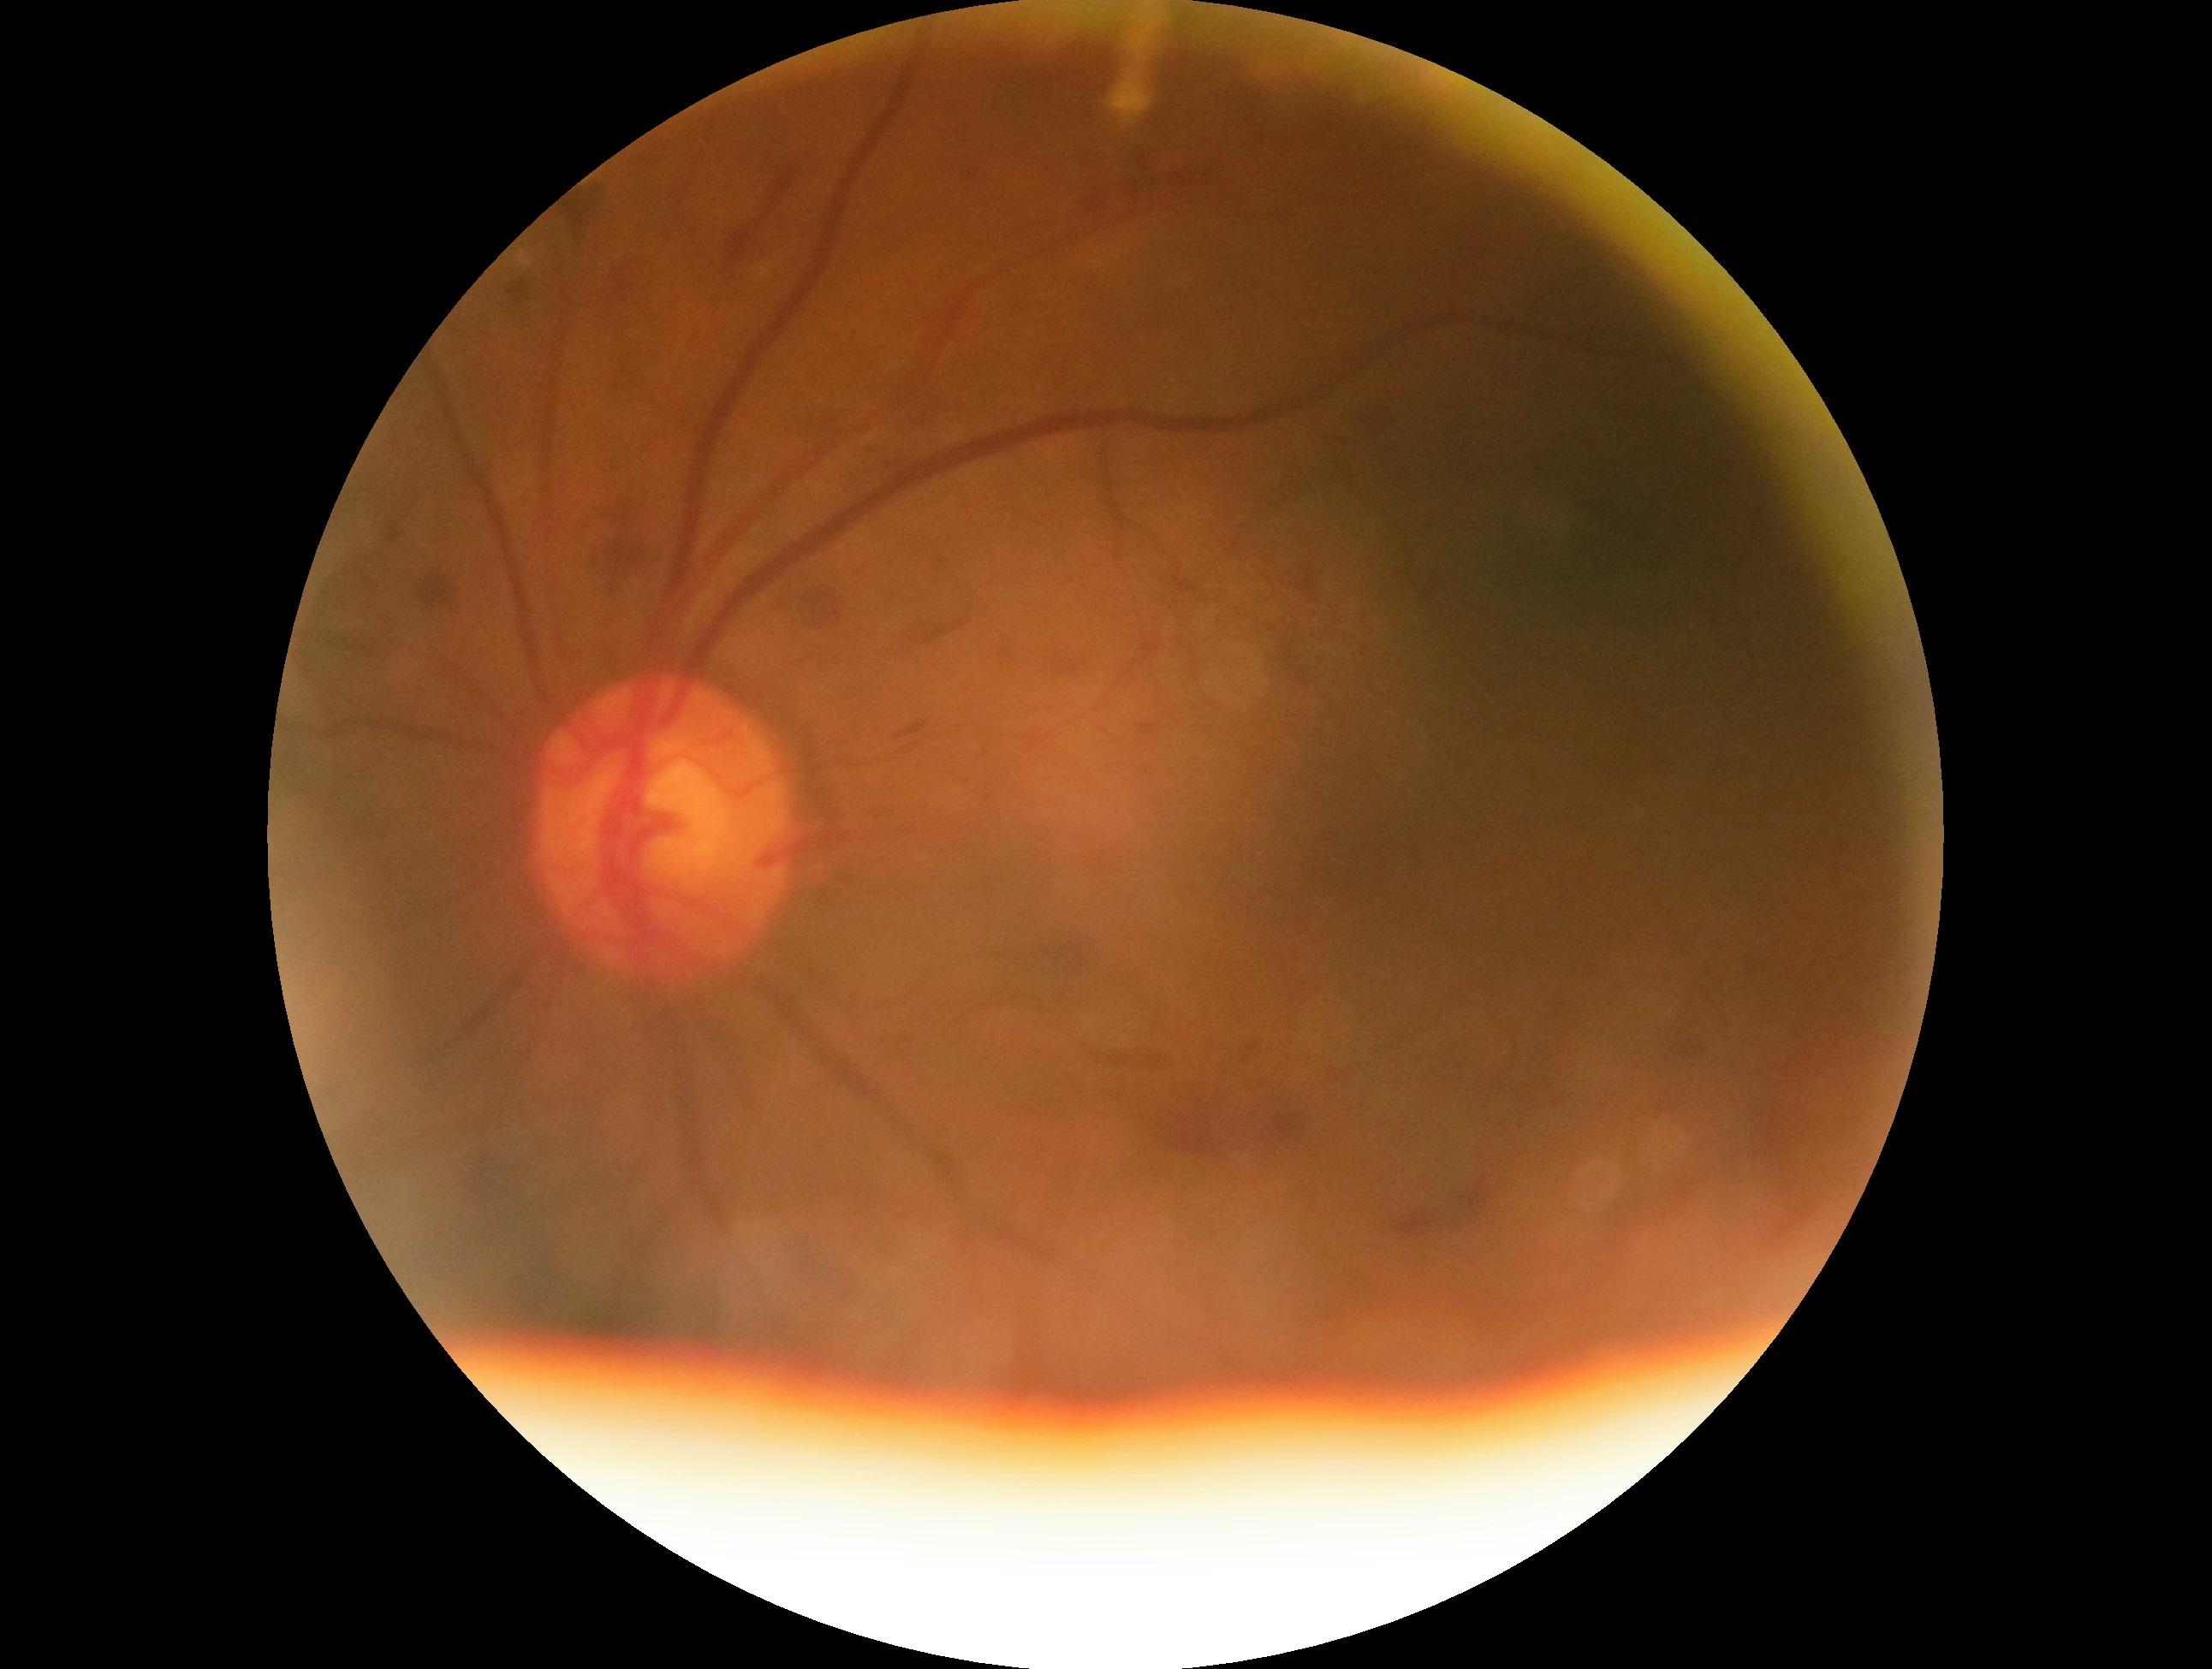 {
  "dr_grade": "2 — more than just microaneurysms but less than severe NPDR"
}